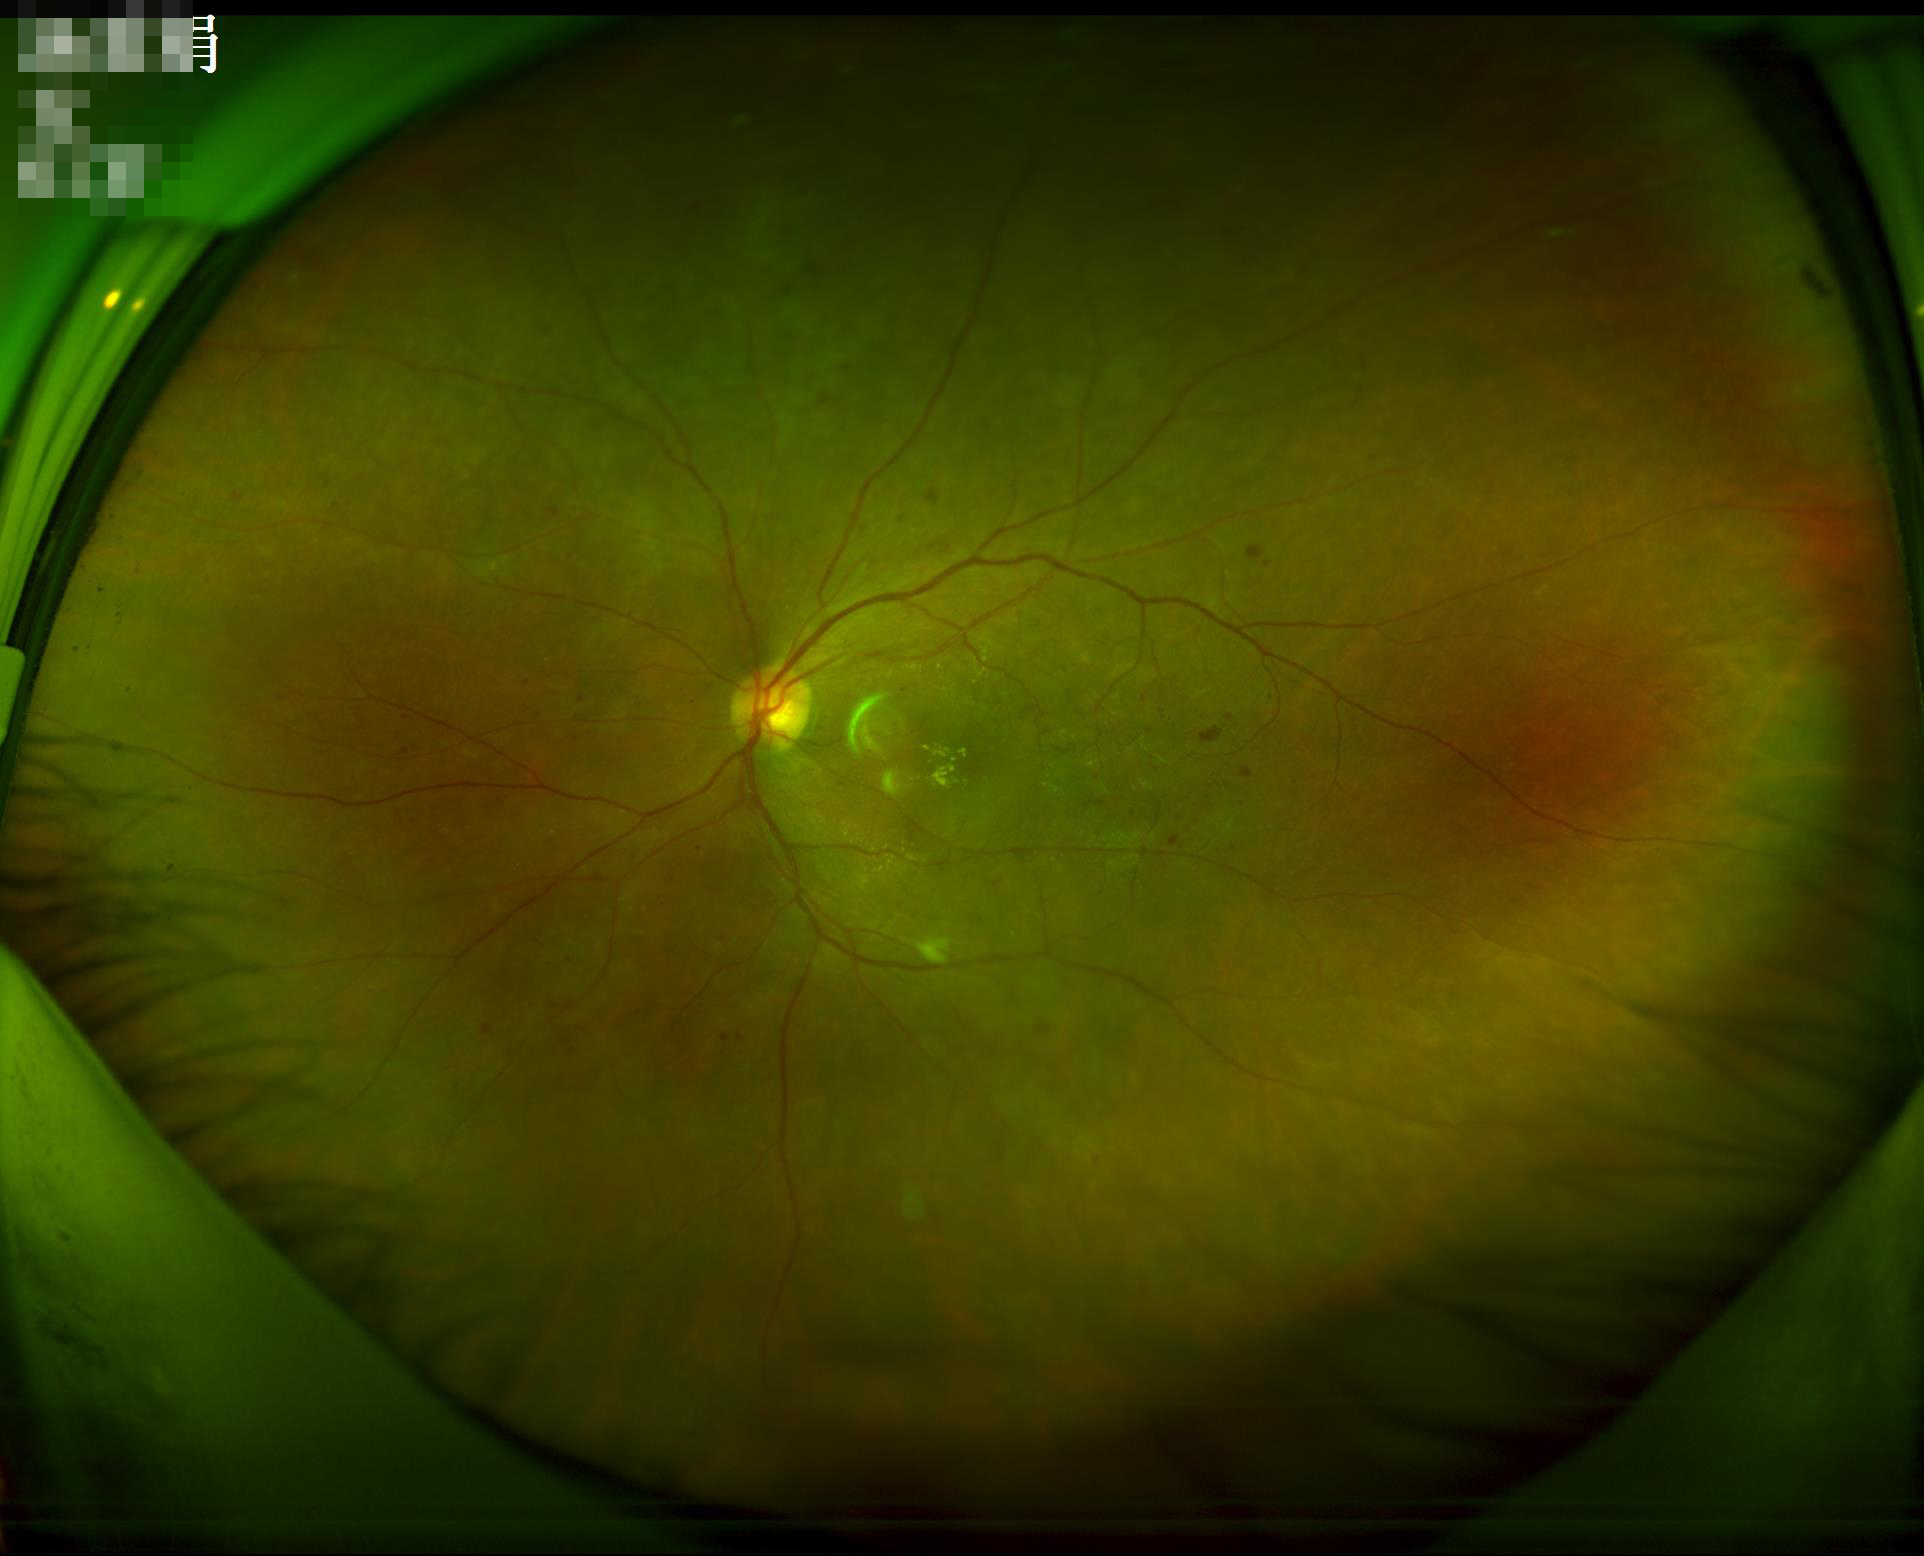
Quality assessment: overall: adequate; sharpness: clear; contrast: good.